Wide-field fundus photograph of an infant:
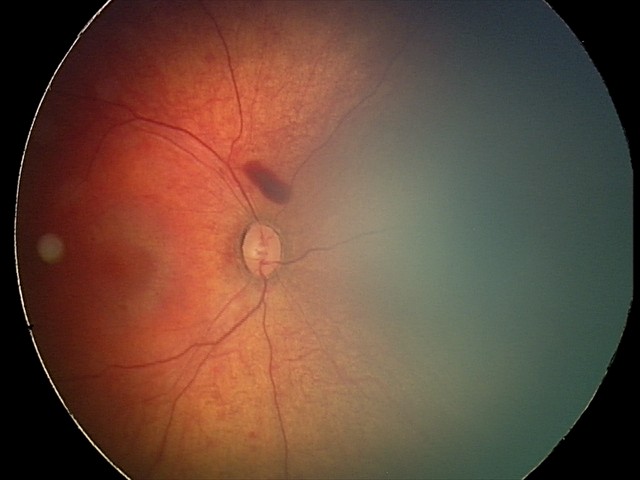

Assessment = retinal hemorrhages.